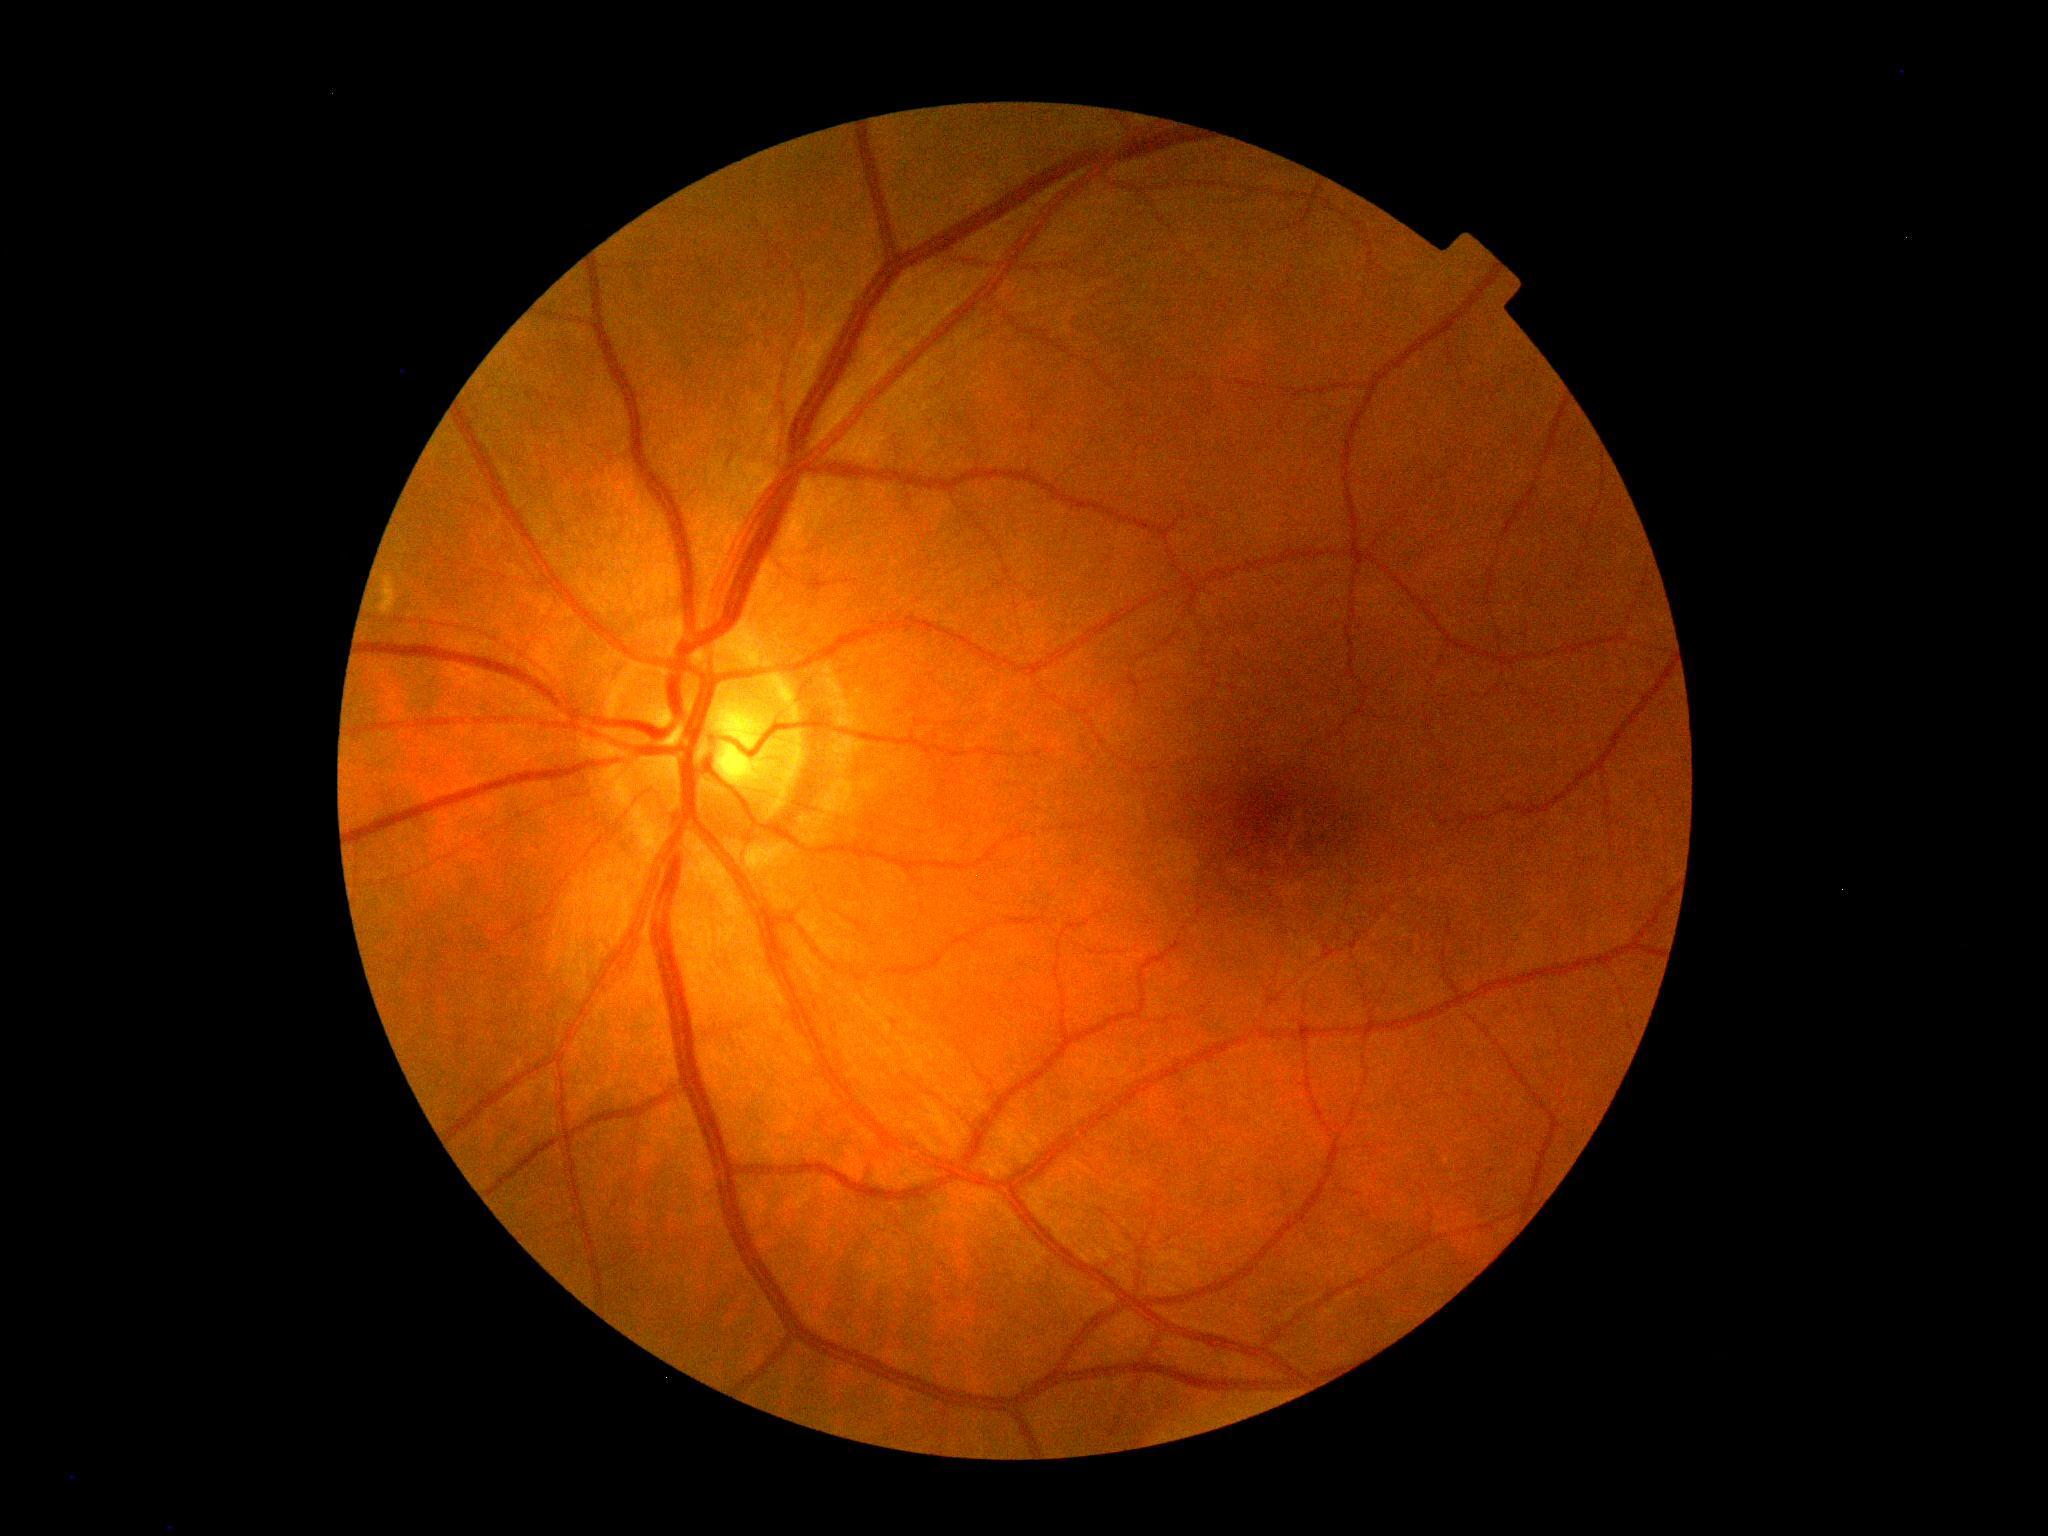 Findings:
- retinopathy — grade 0